Retinal fundus photograph
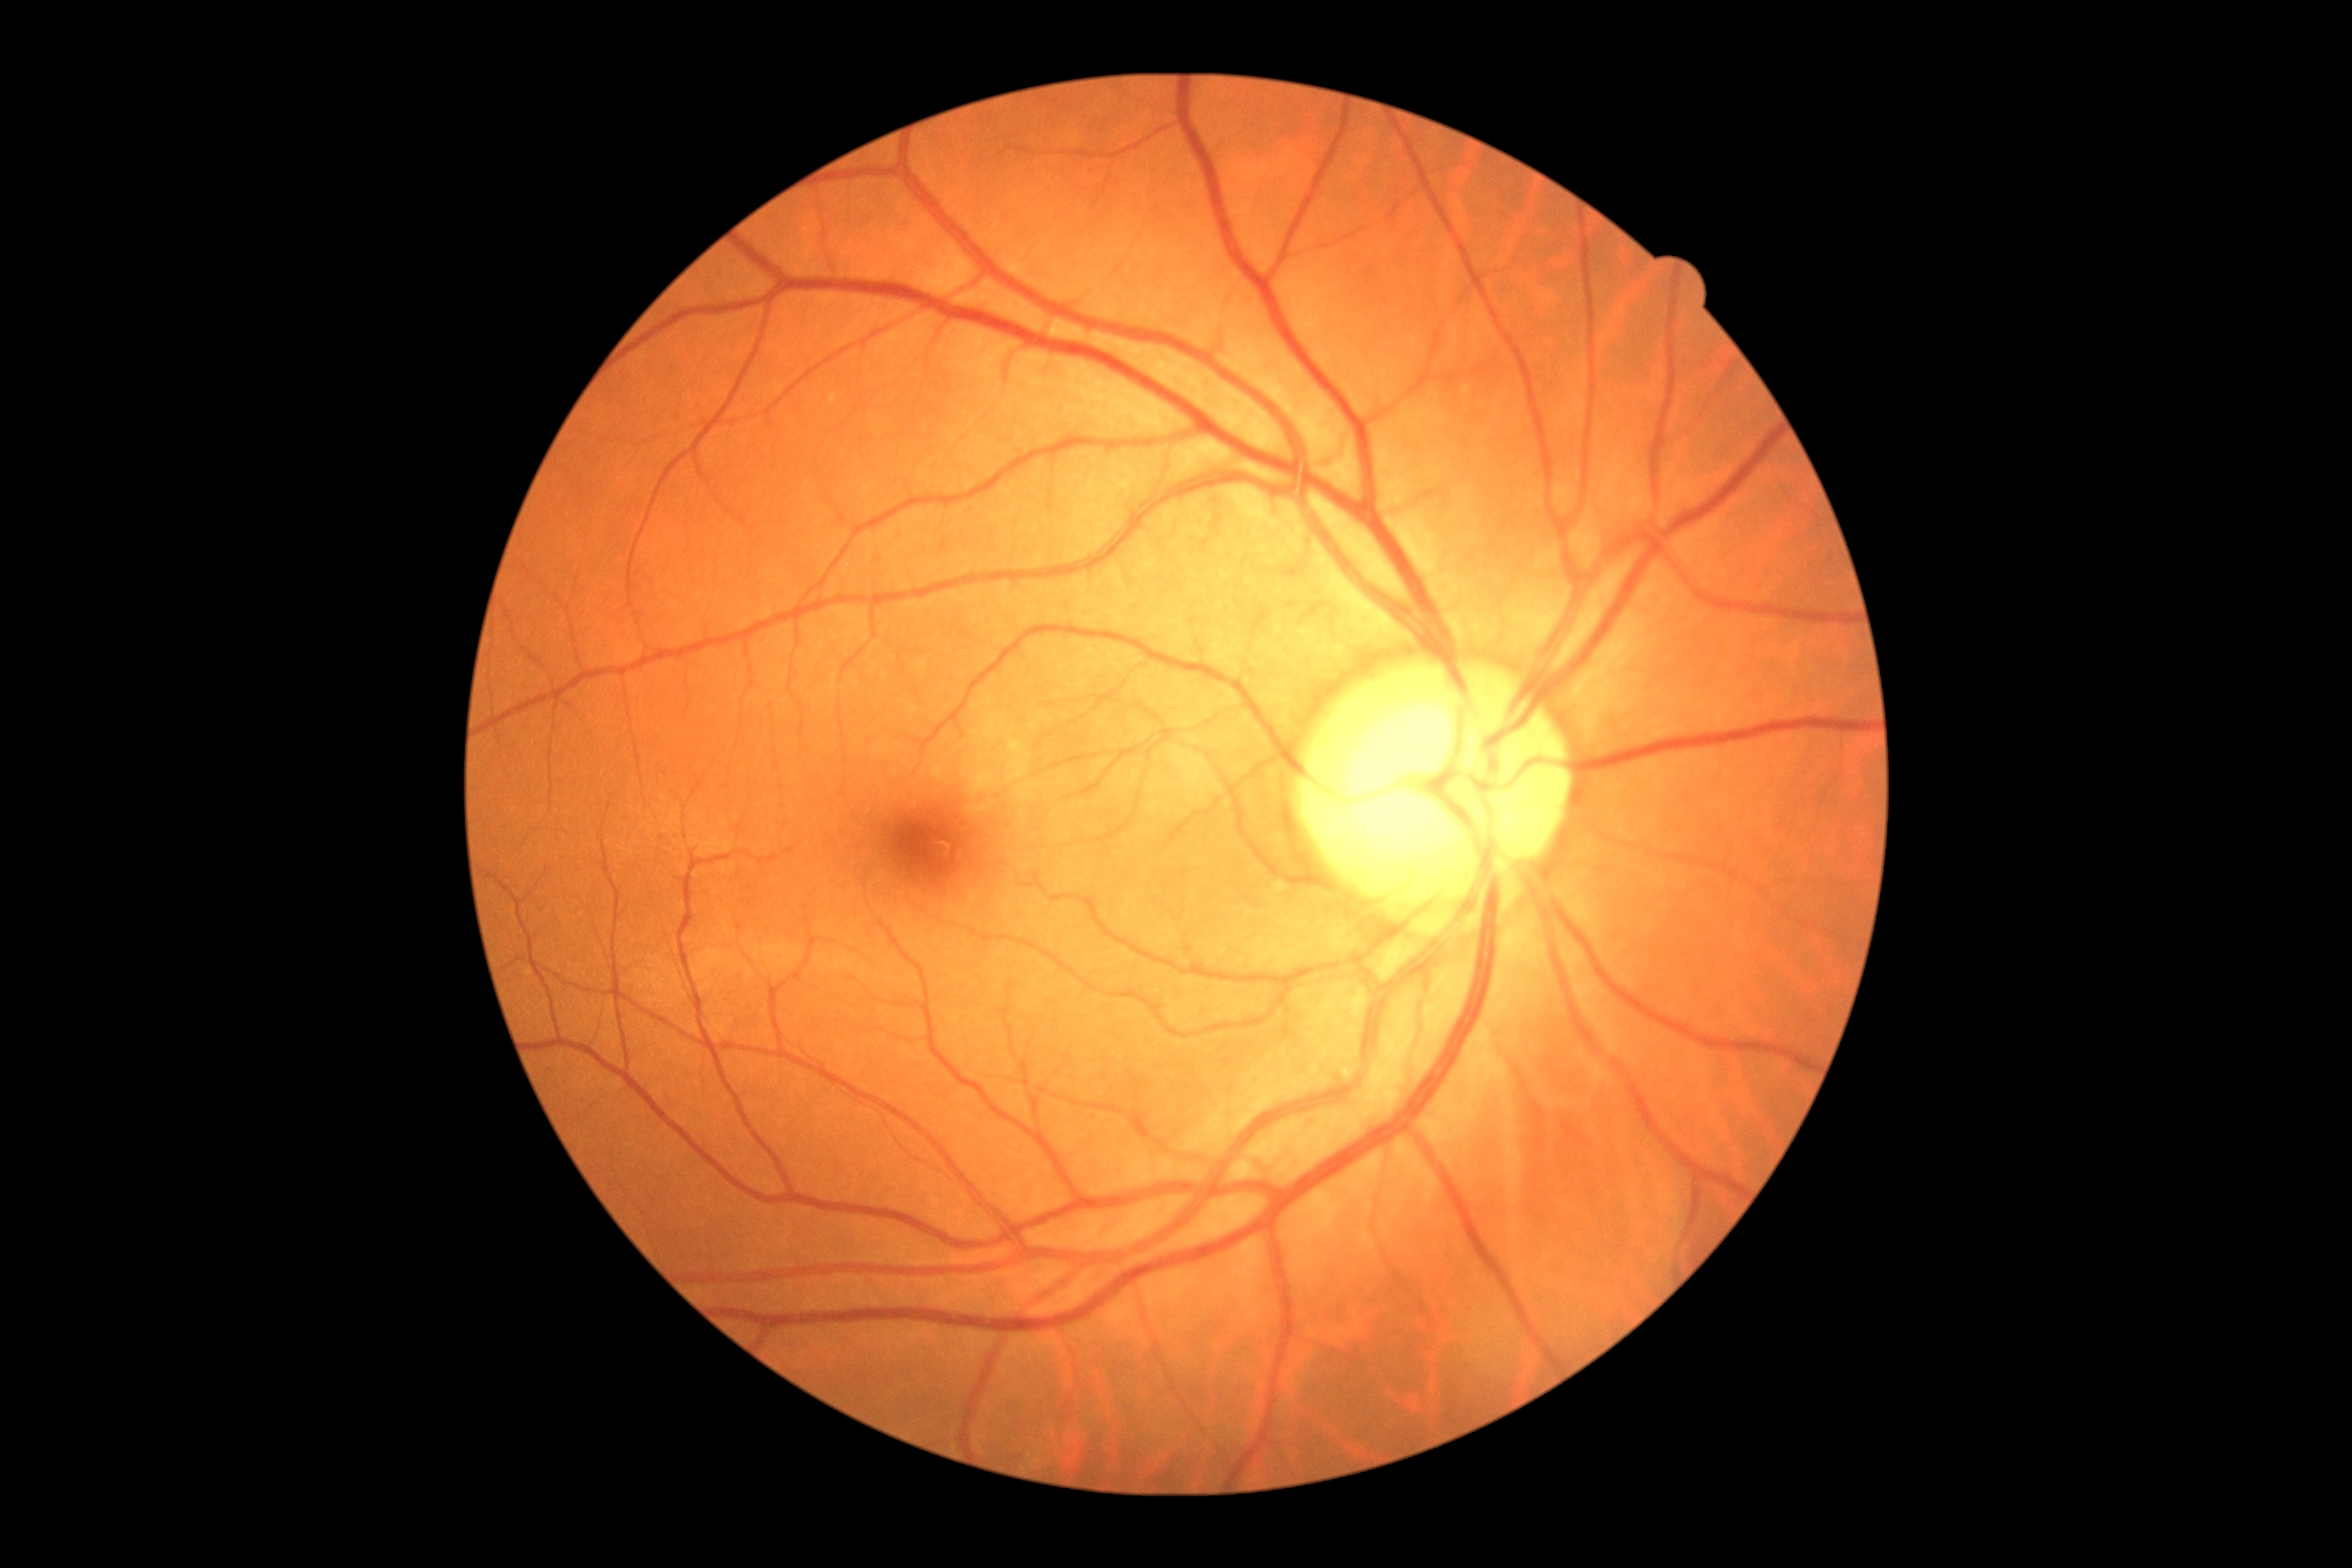
Retinopathy grade is 0 (no apparent retinopathy). No diabetic retinal disease findings.